Retinal fundus photograph · 45-degree field of view · image size 1932x1910:
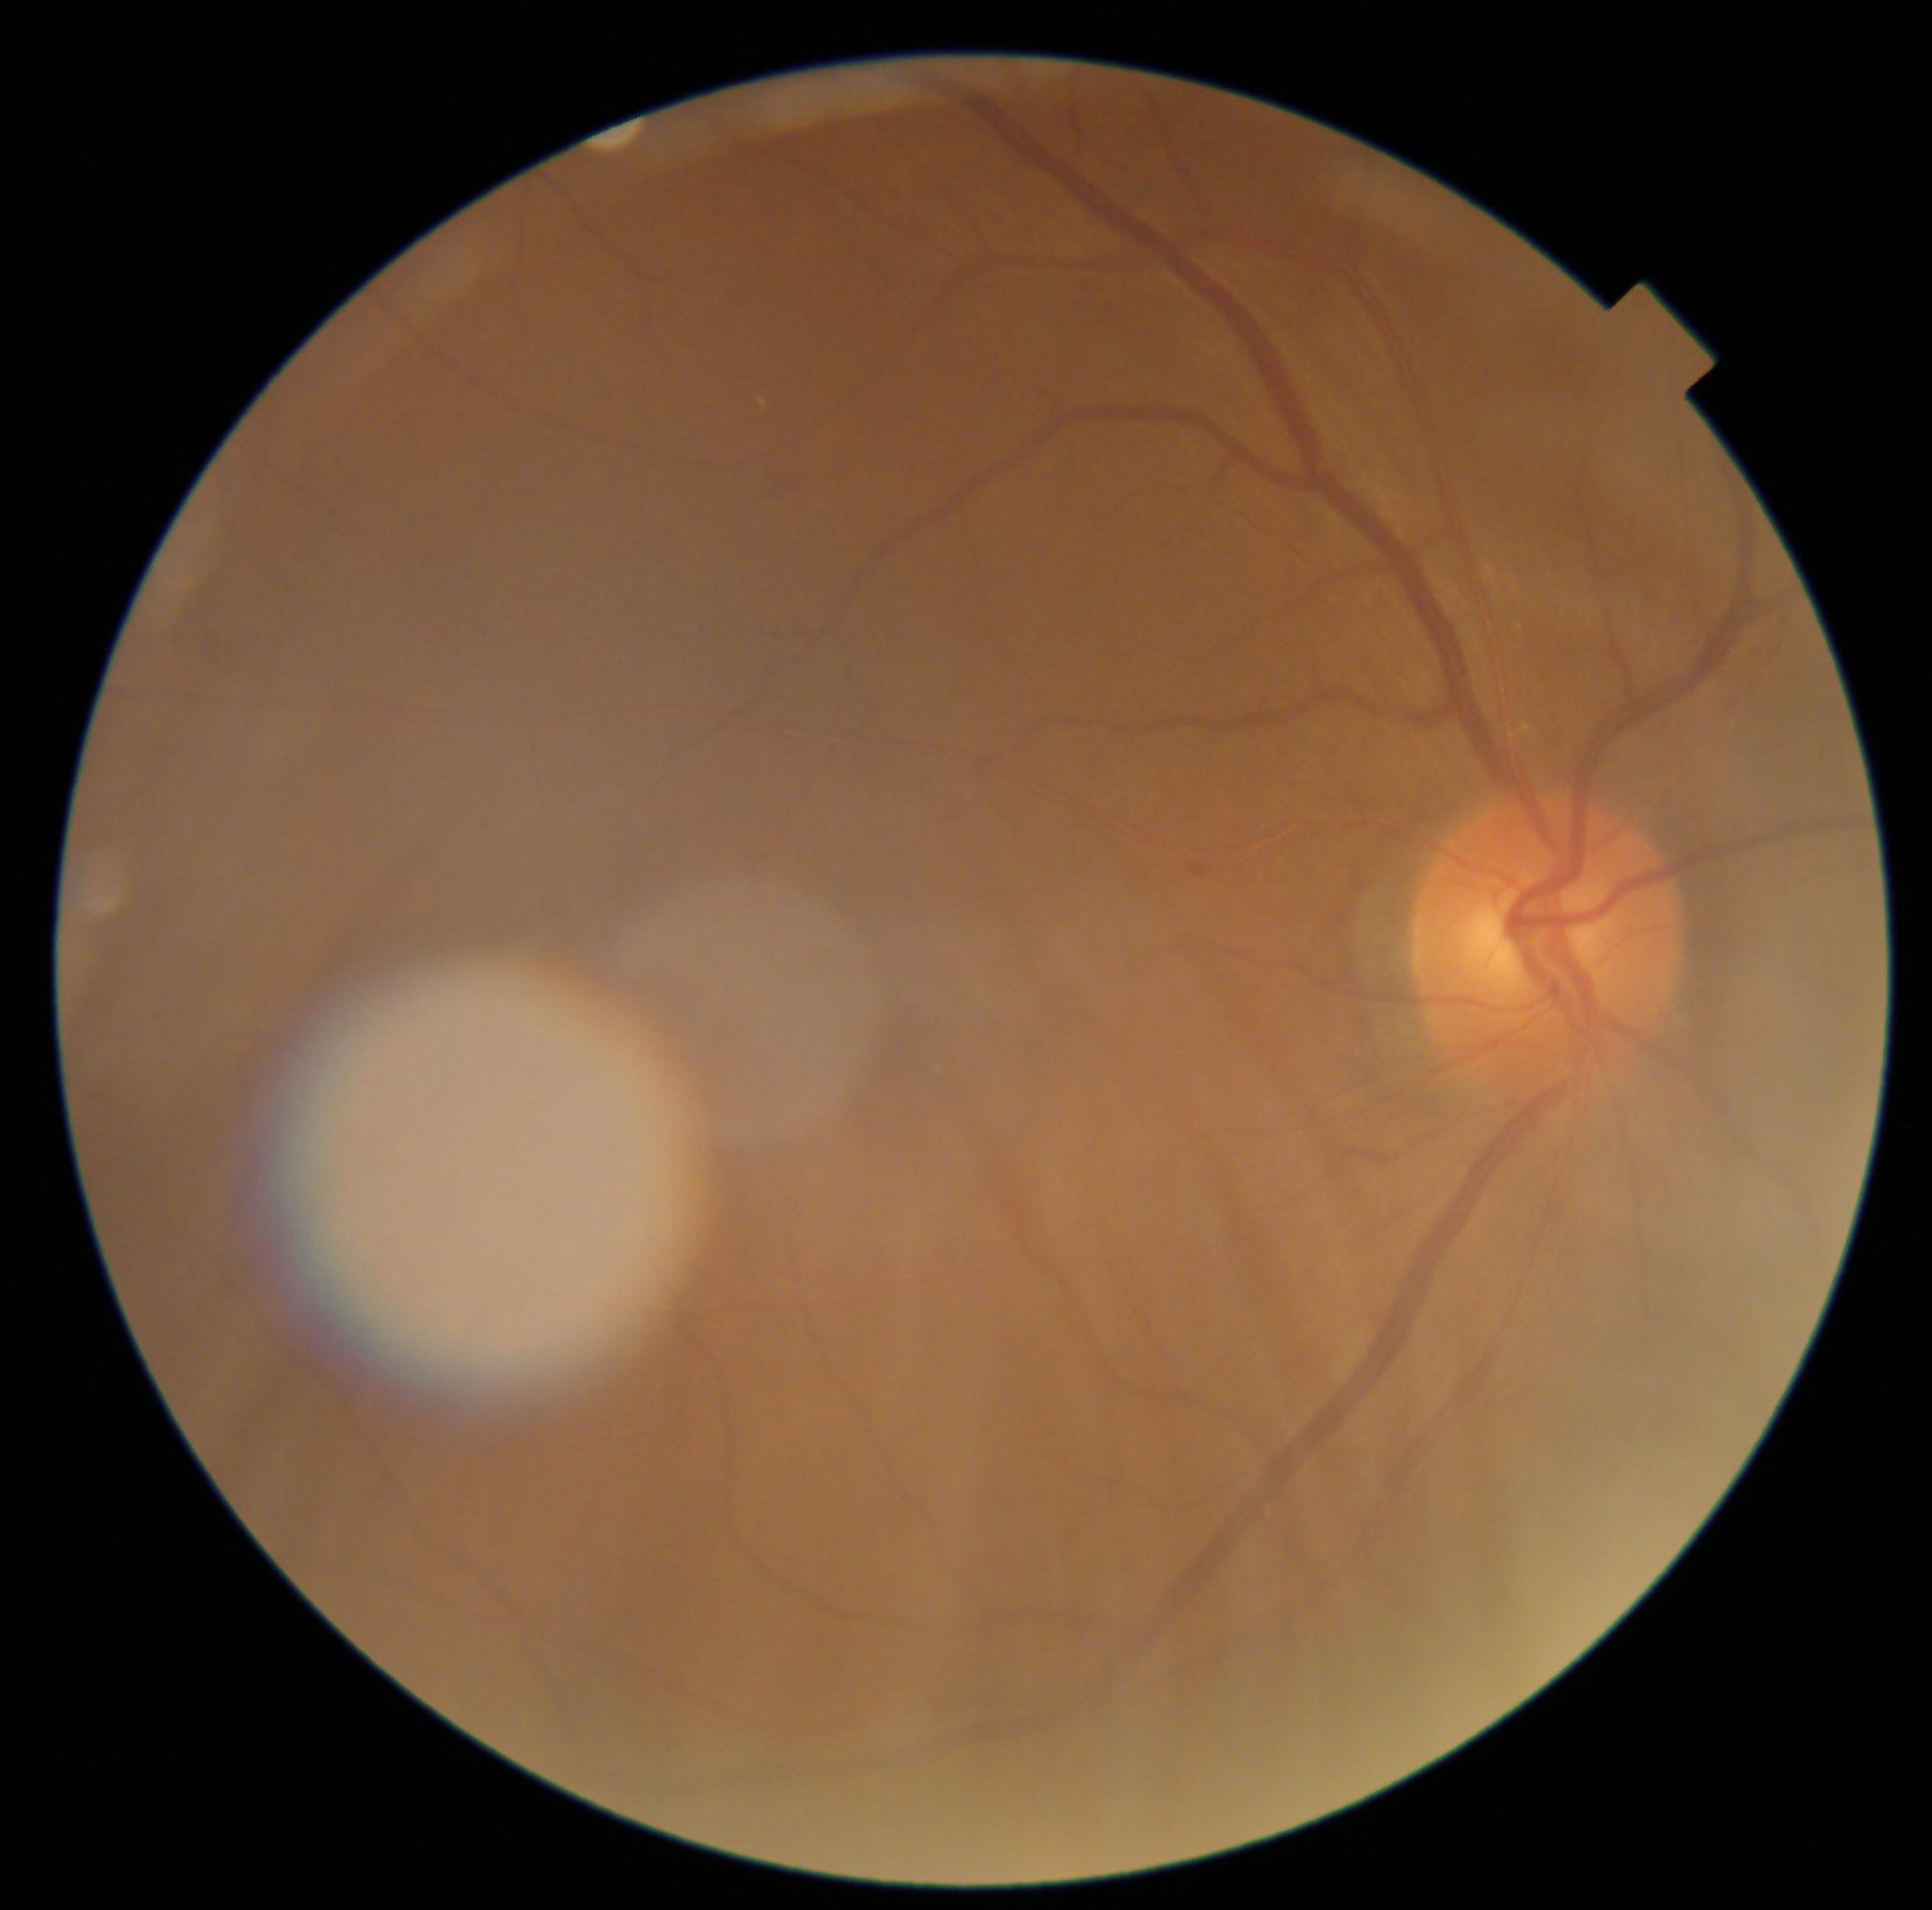

DR stage: mild non-proliferative diabetic retinopathy (grade 1) — presence of microaneurysms only.